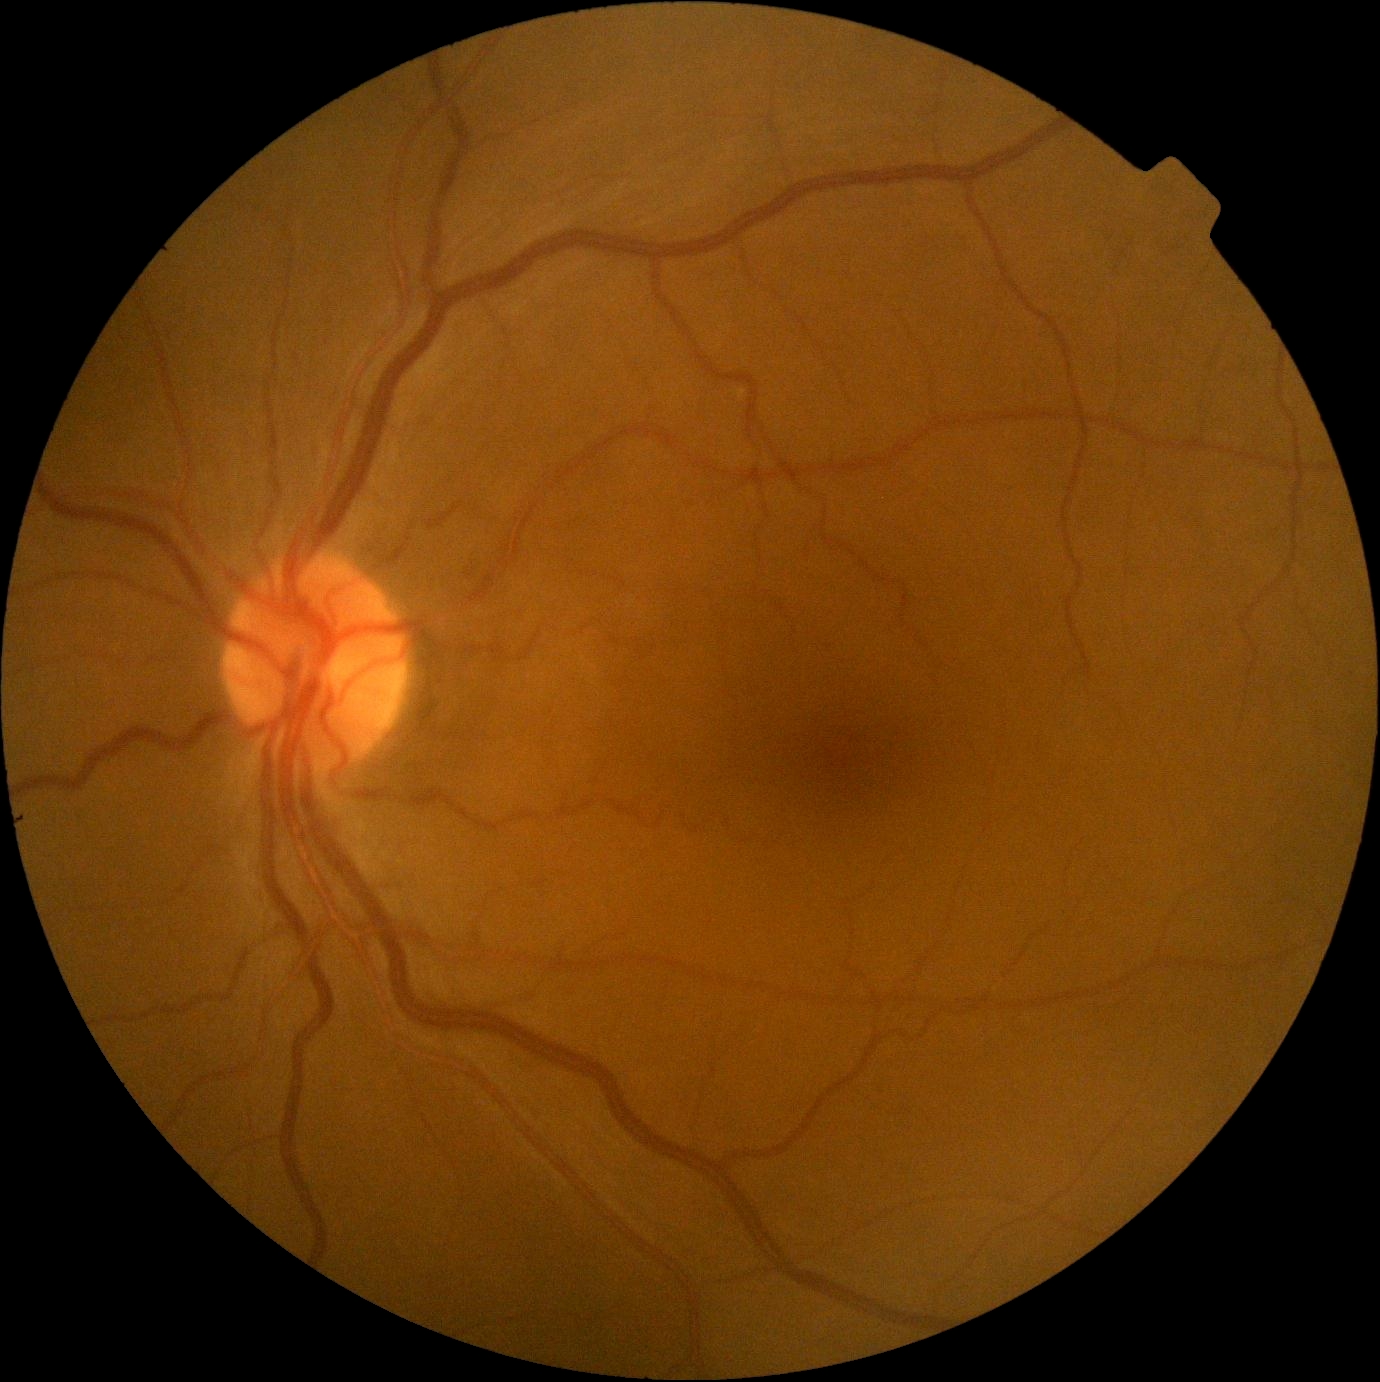
Retinopathy: 0/4.